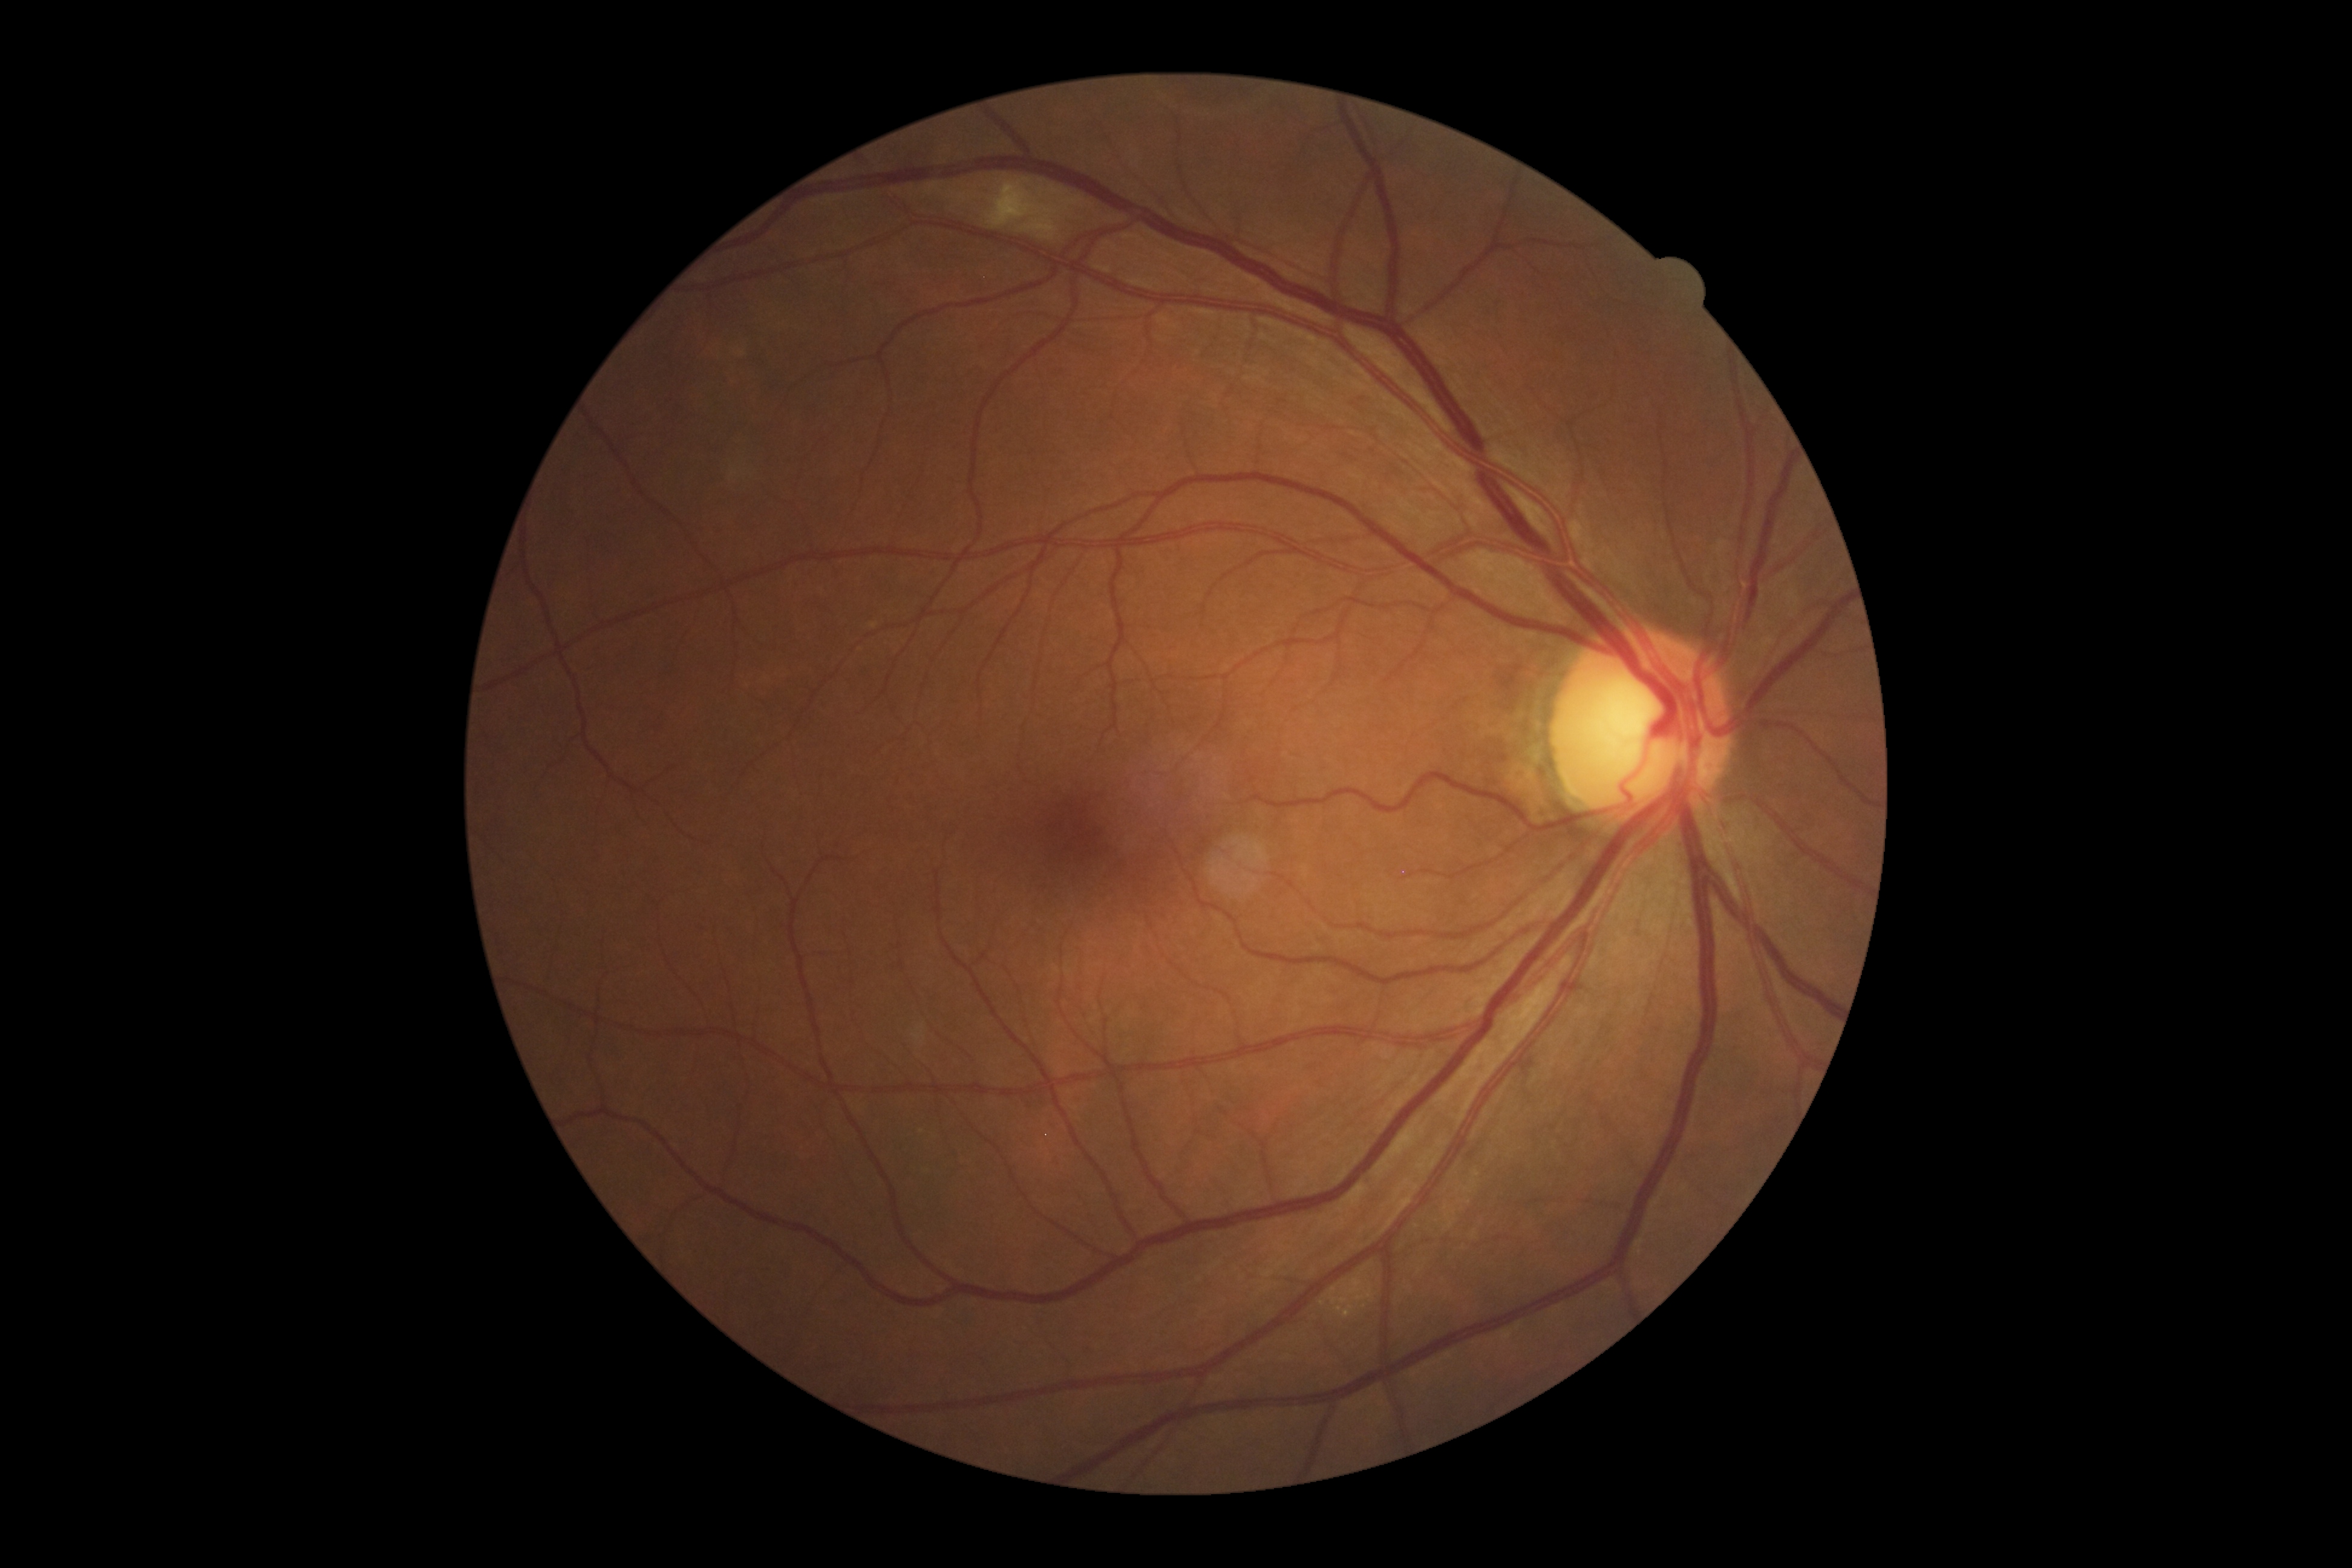 DR class: non-proliferative diabetic retinopathy. DR stage is grade 2.